DR severity per modified Davis staging
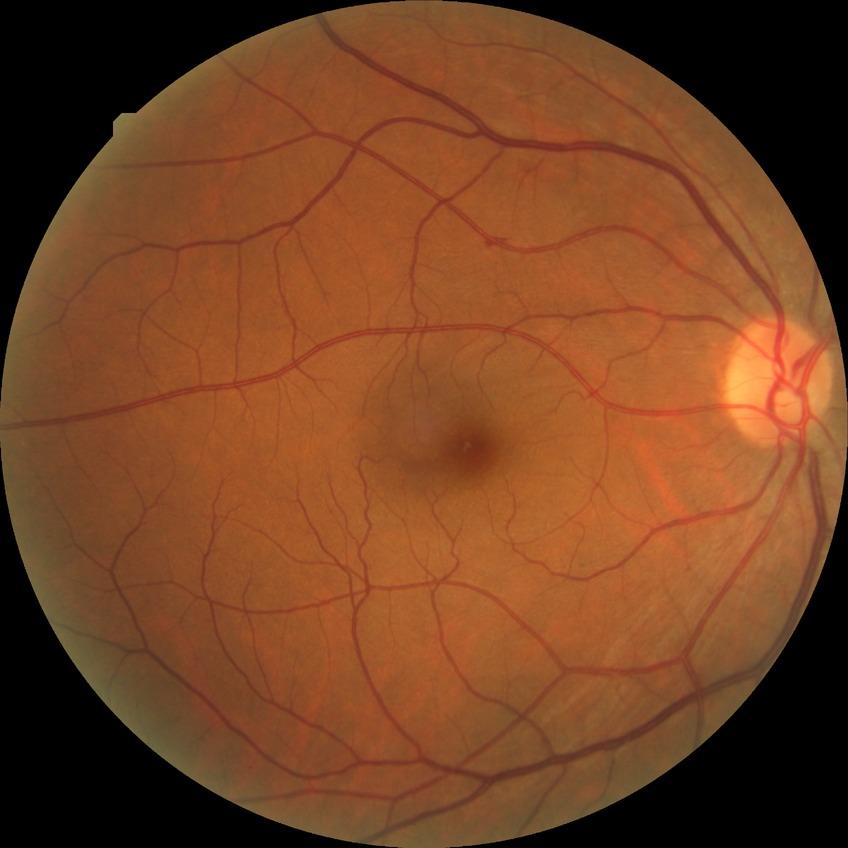
Diabetic retinopathy (DR) is simple diabetic retinopathy (SDR).